2228 x 1652 pixels
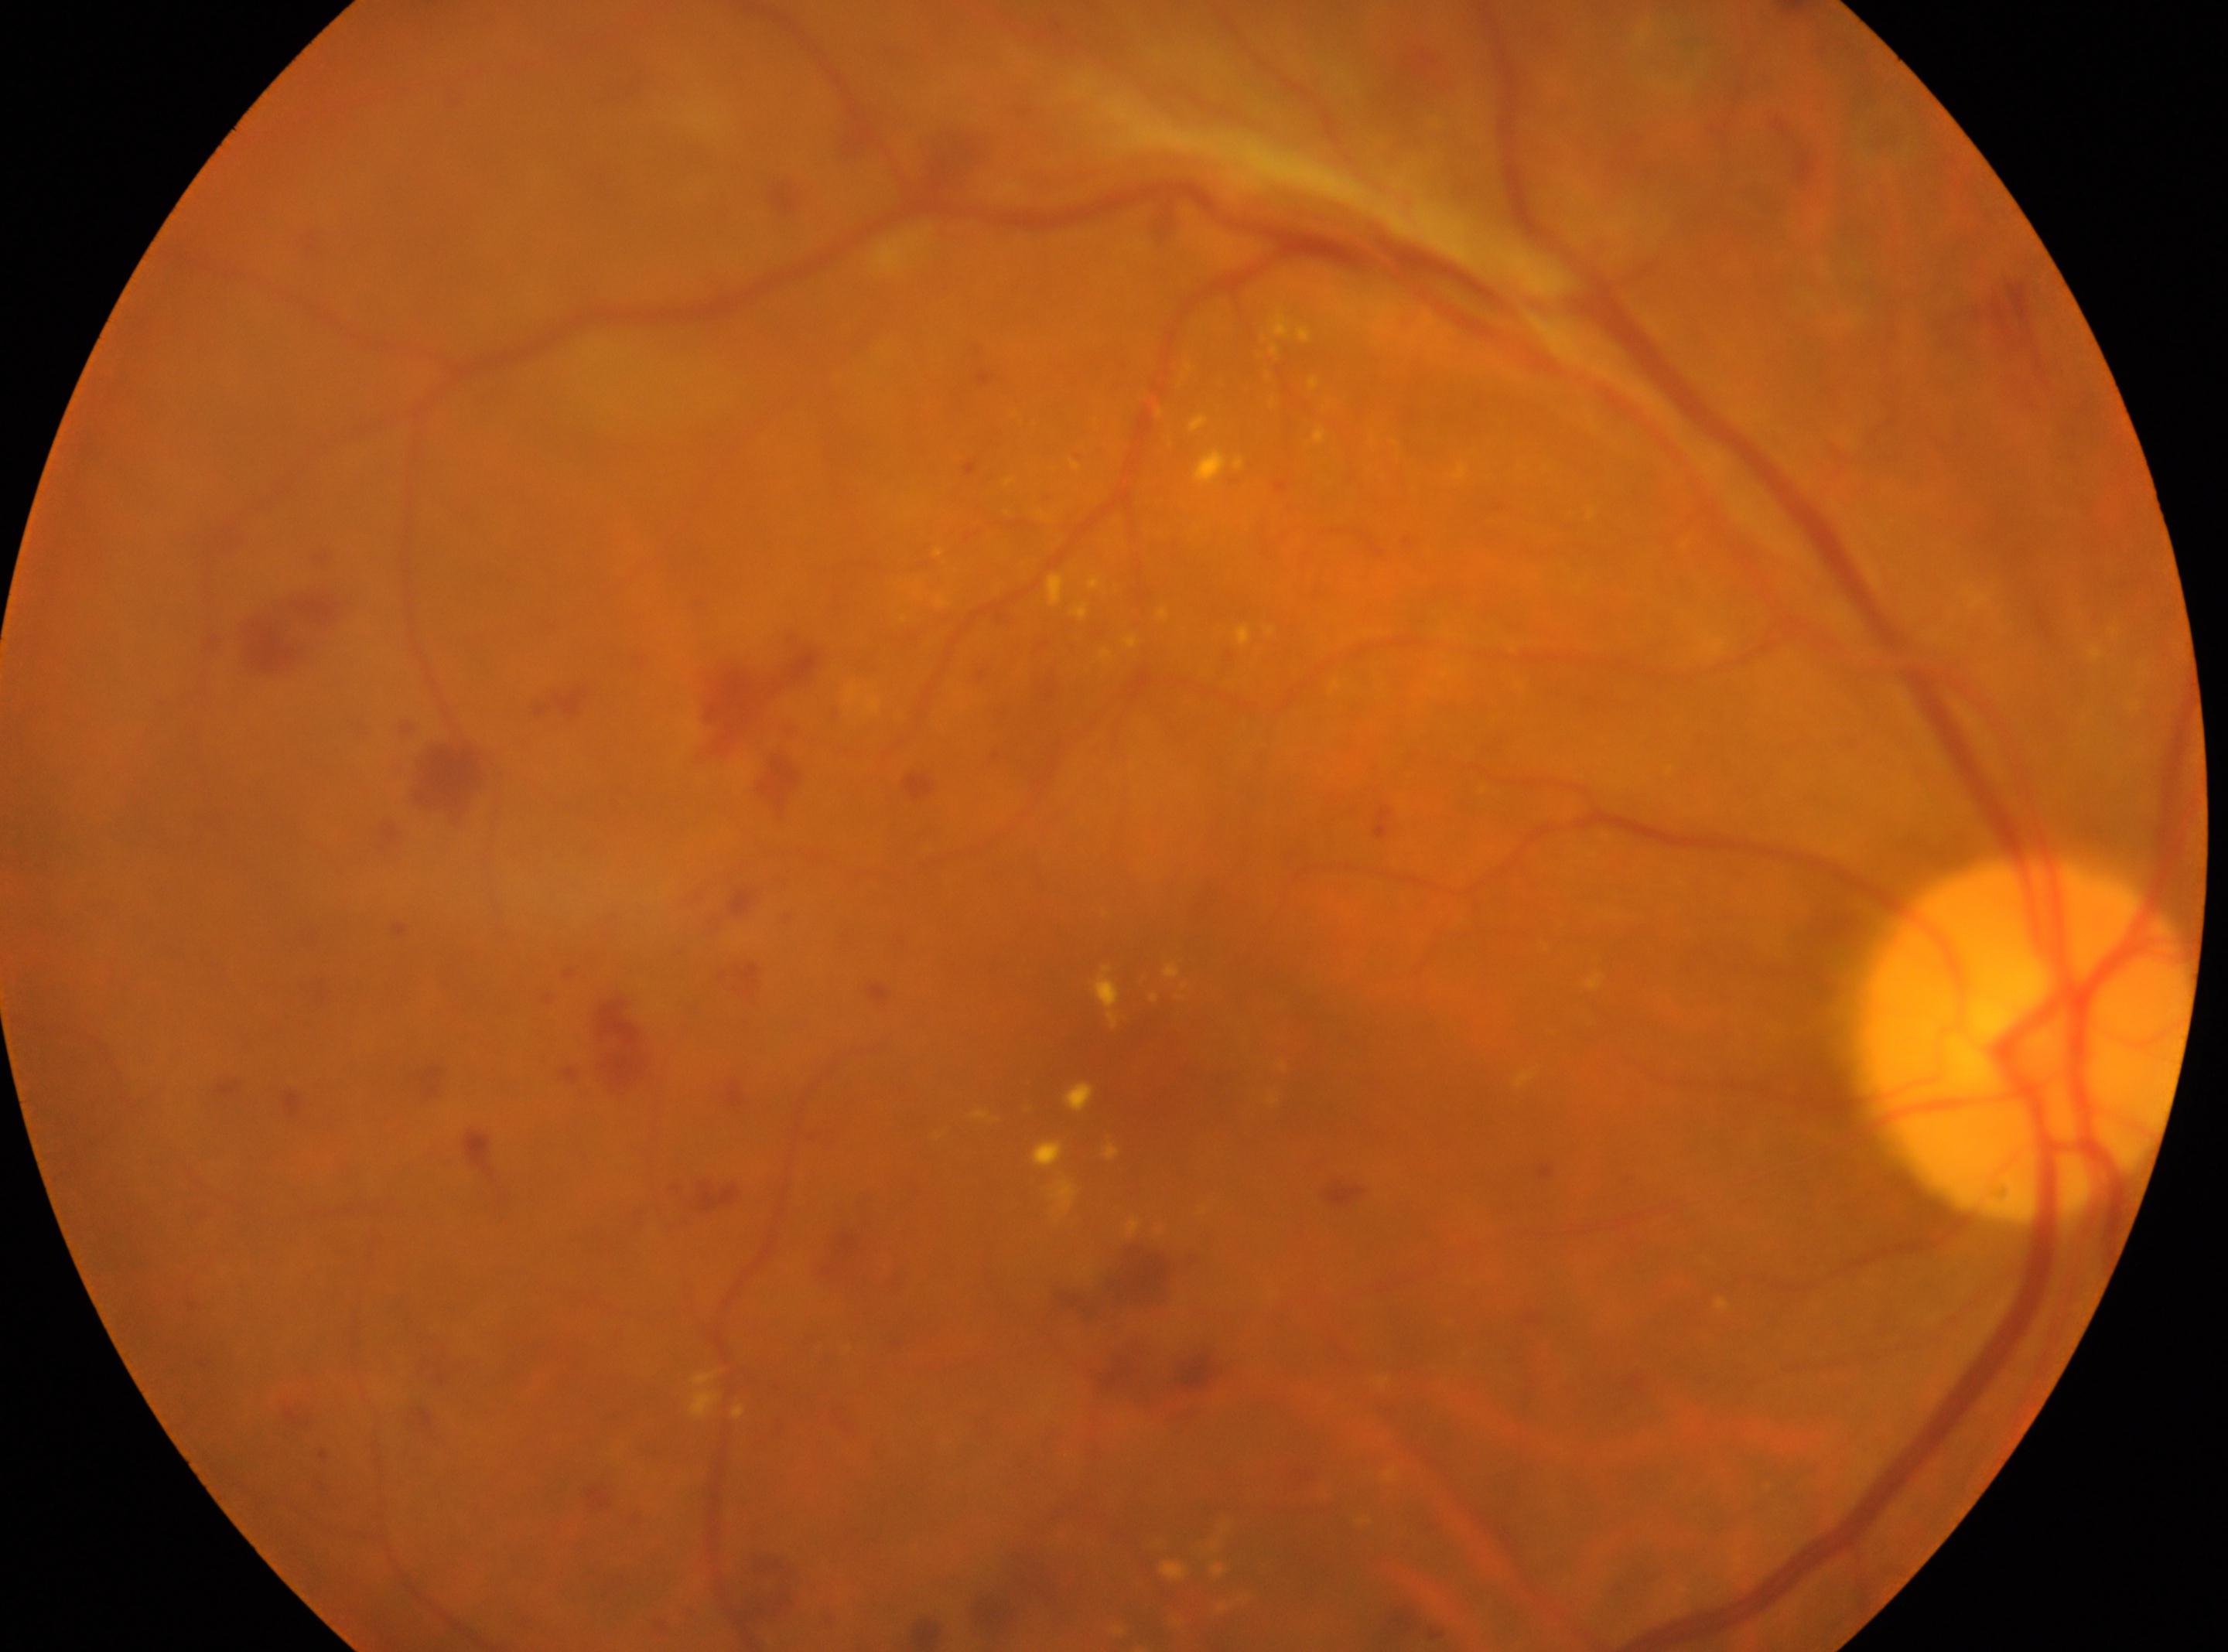
Diabetic retinopathy (DR) is 4/4.
Optic disc: (2029,1039).
Fovea: (1143,1058).
Imaged eye: the right eye.